Non-mydriatic acquisition — 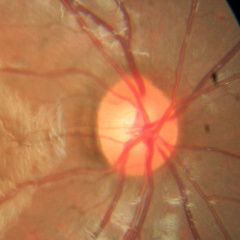
Q: Does this eye have glaucoma?
A: No glaucoma.